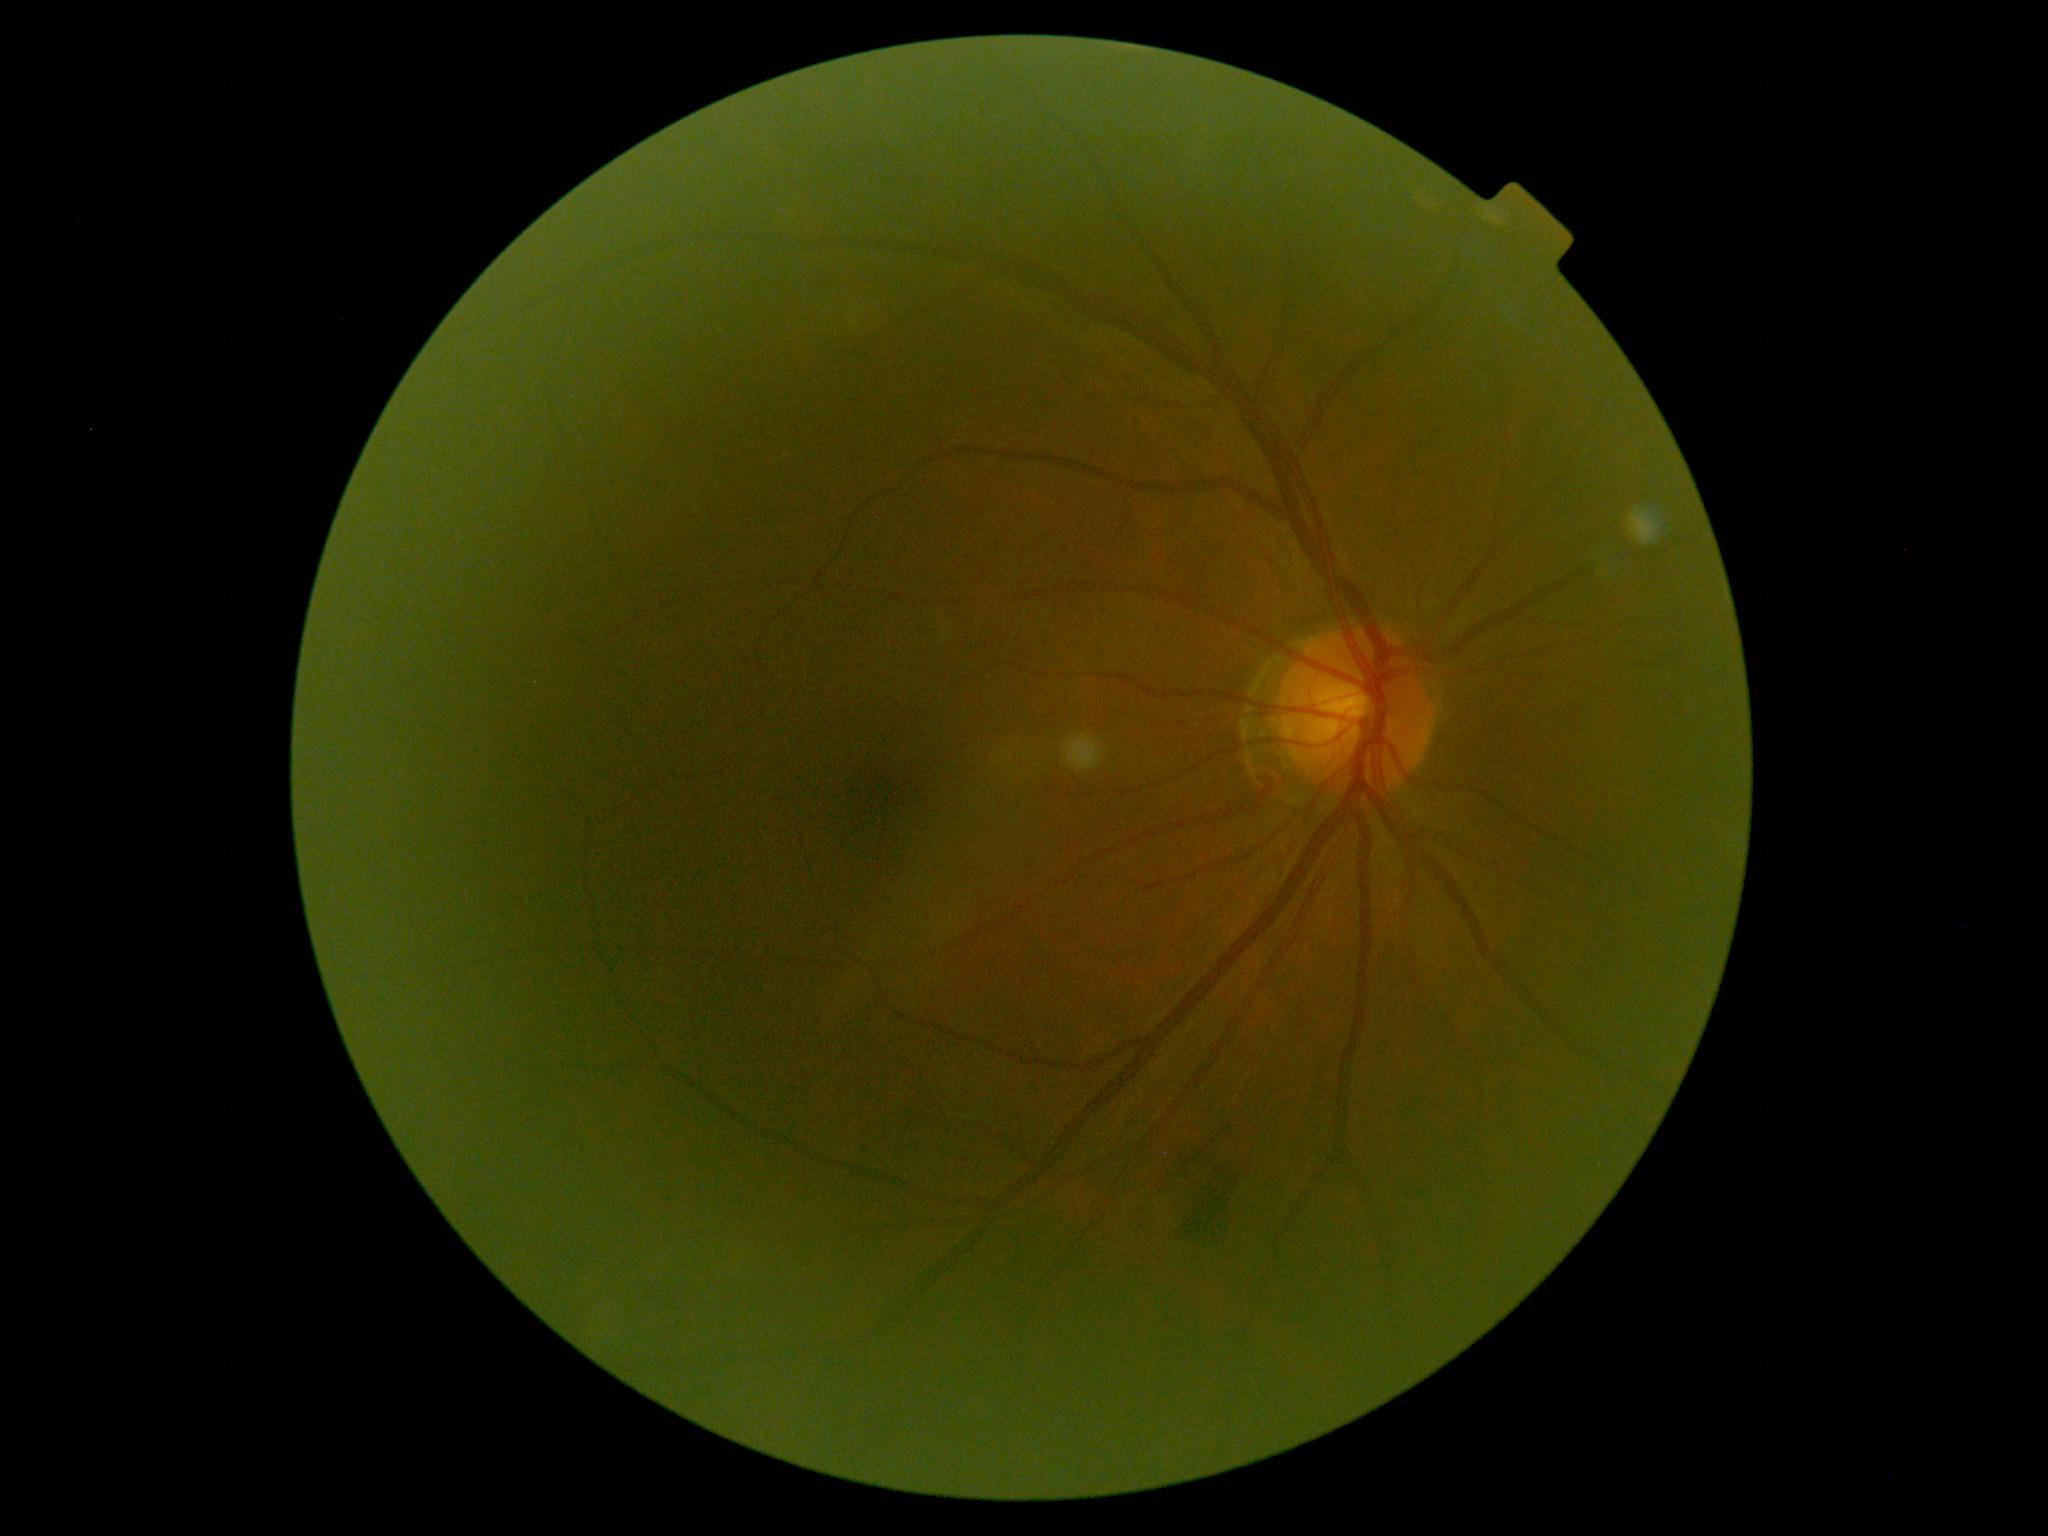

Diabetic retinopathy (DR) is grade 2 (moderate NPDR) — more than just microaneurysms but less than severe NPDR.
DR class: non-proliferative diabetic retinopathy.